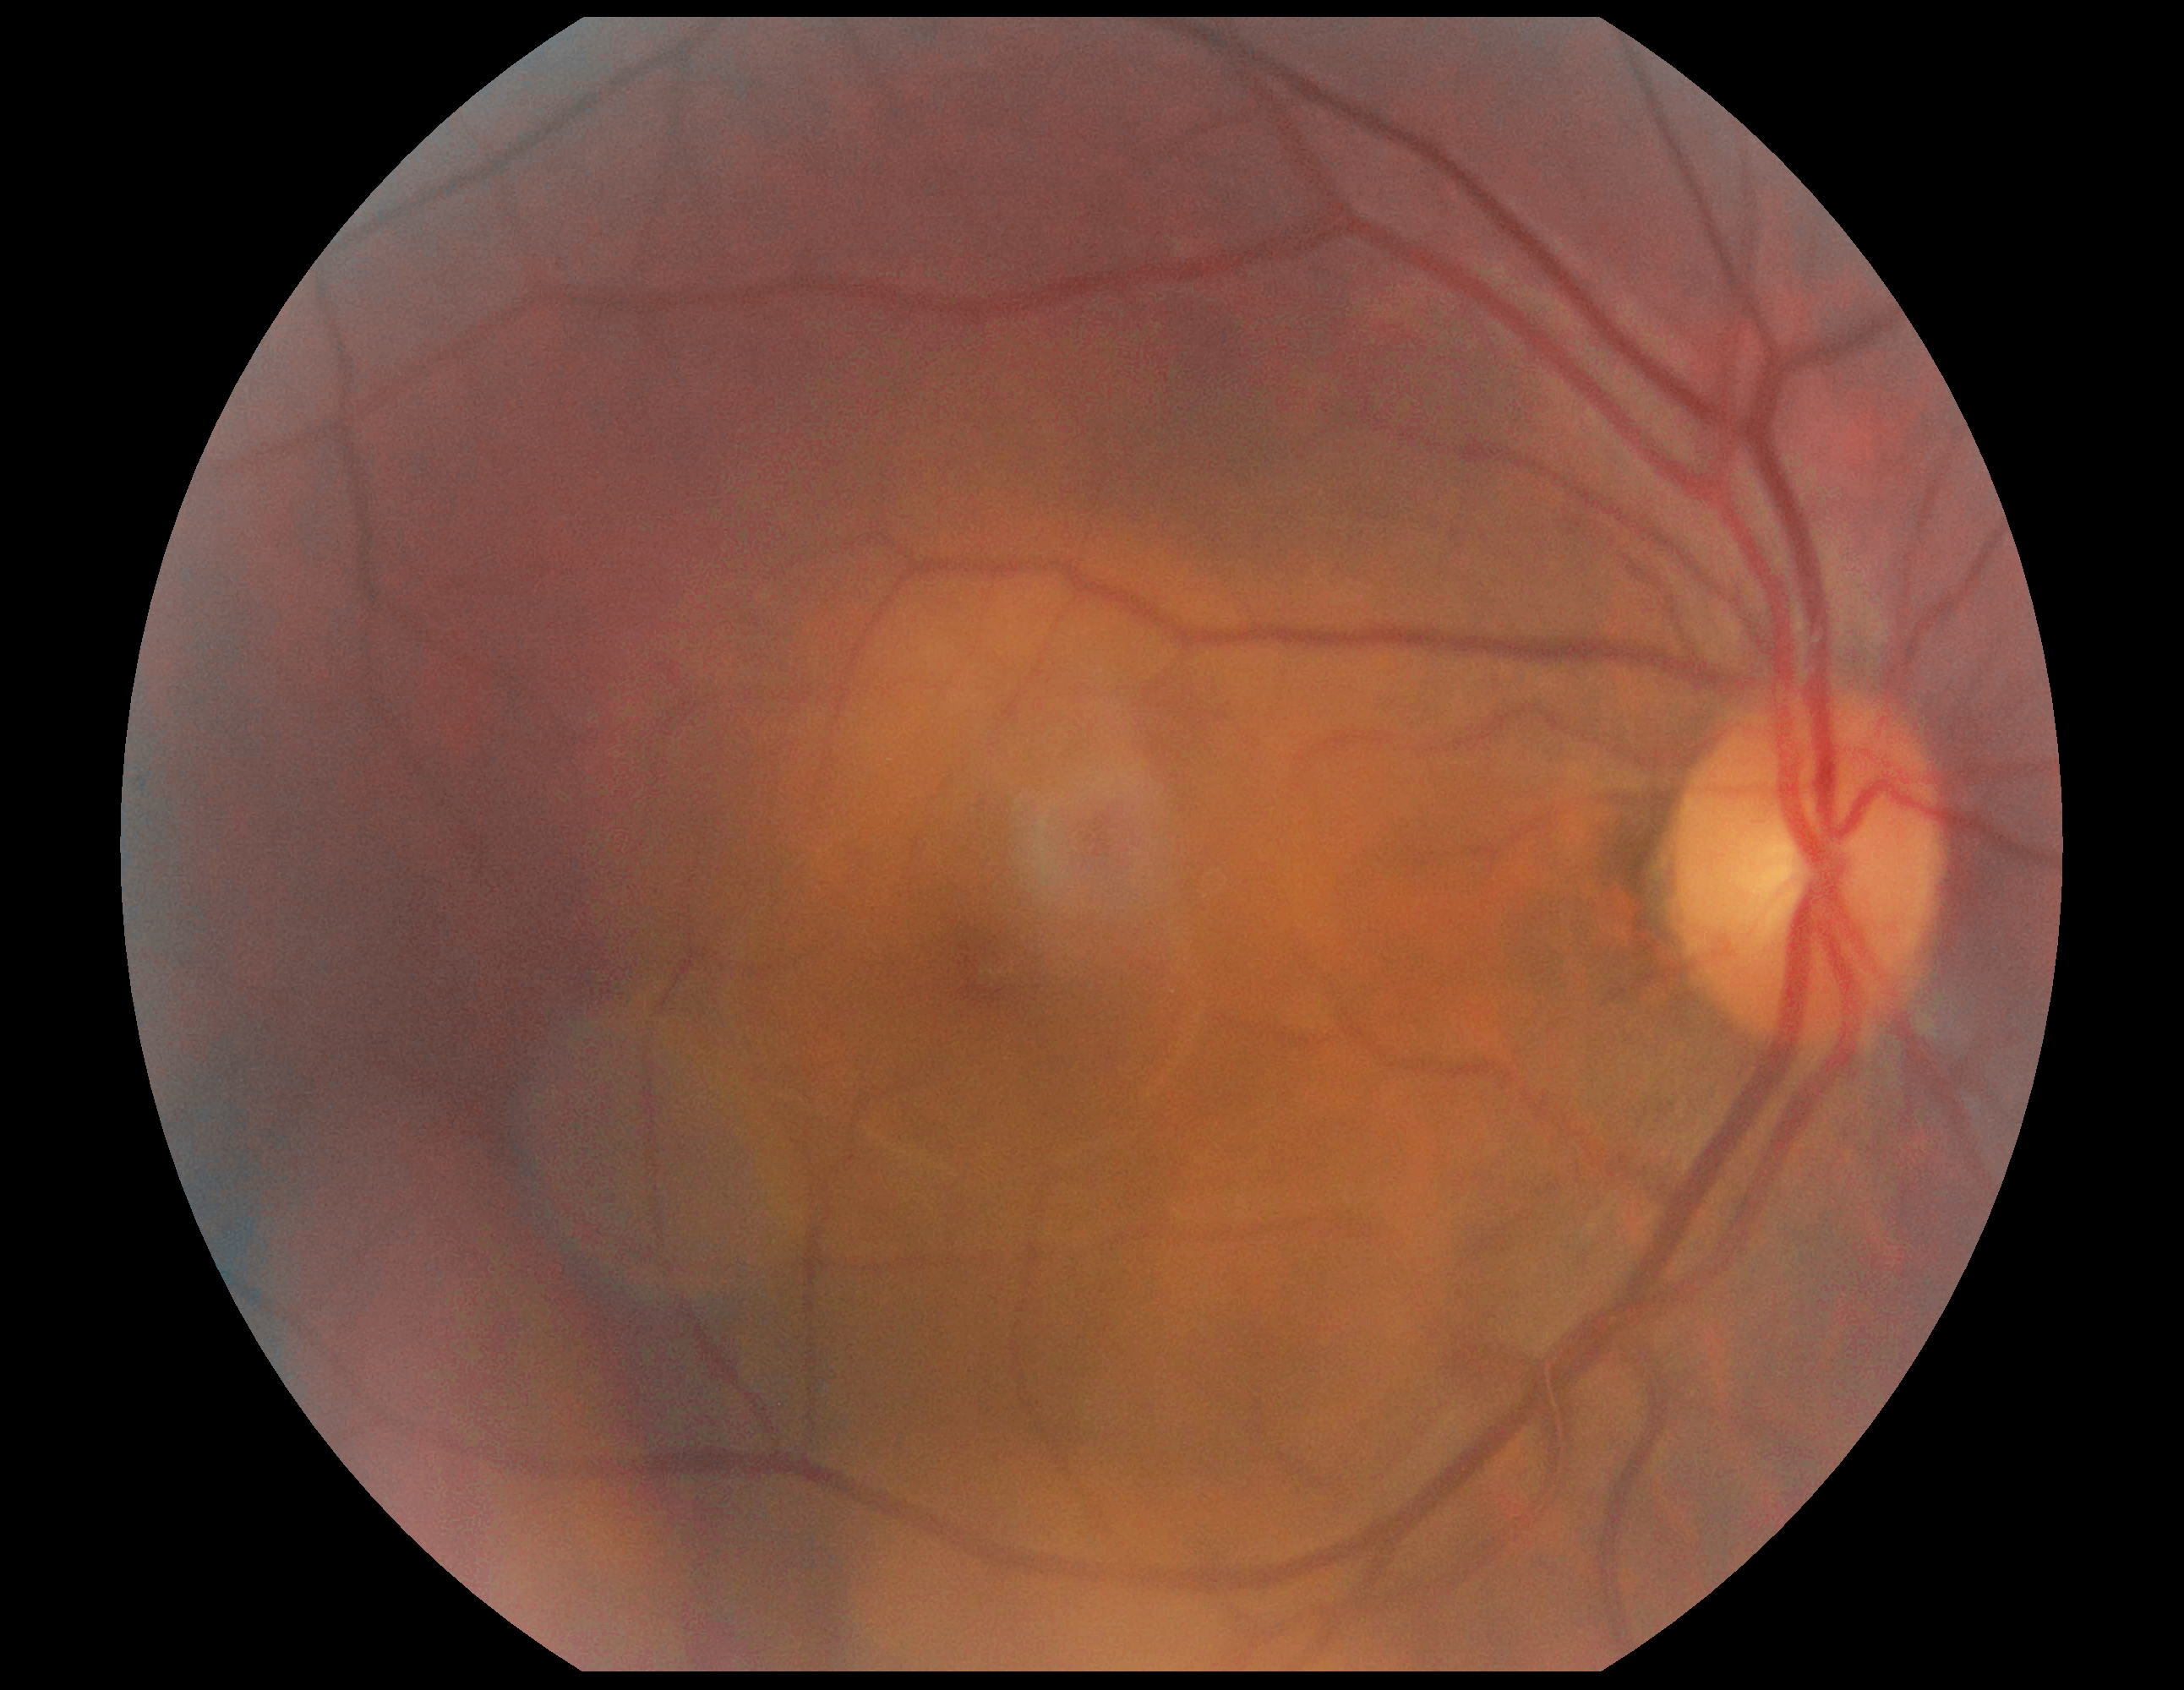 No diabetic retinal disease findings.
Retinopathy grade is 0 (no apparent retinopathy).